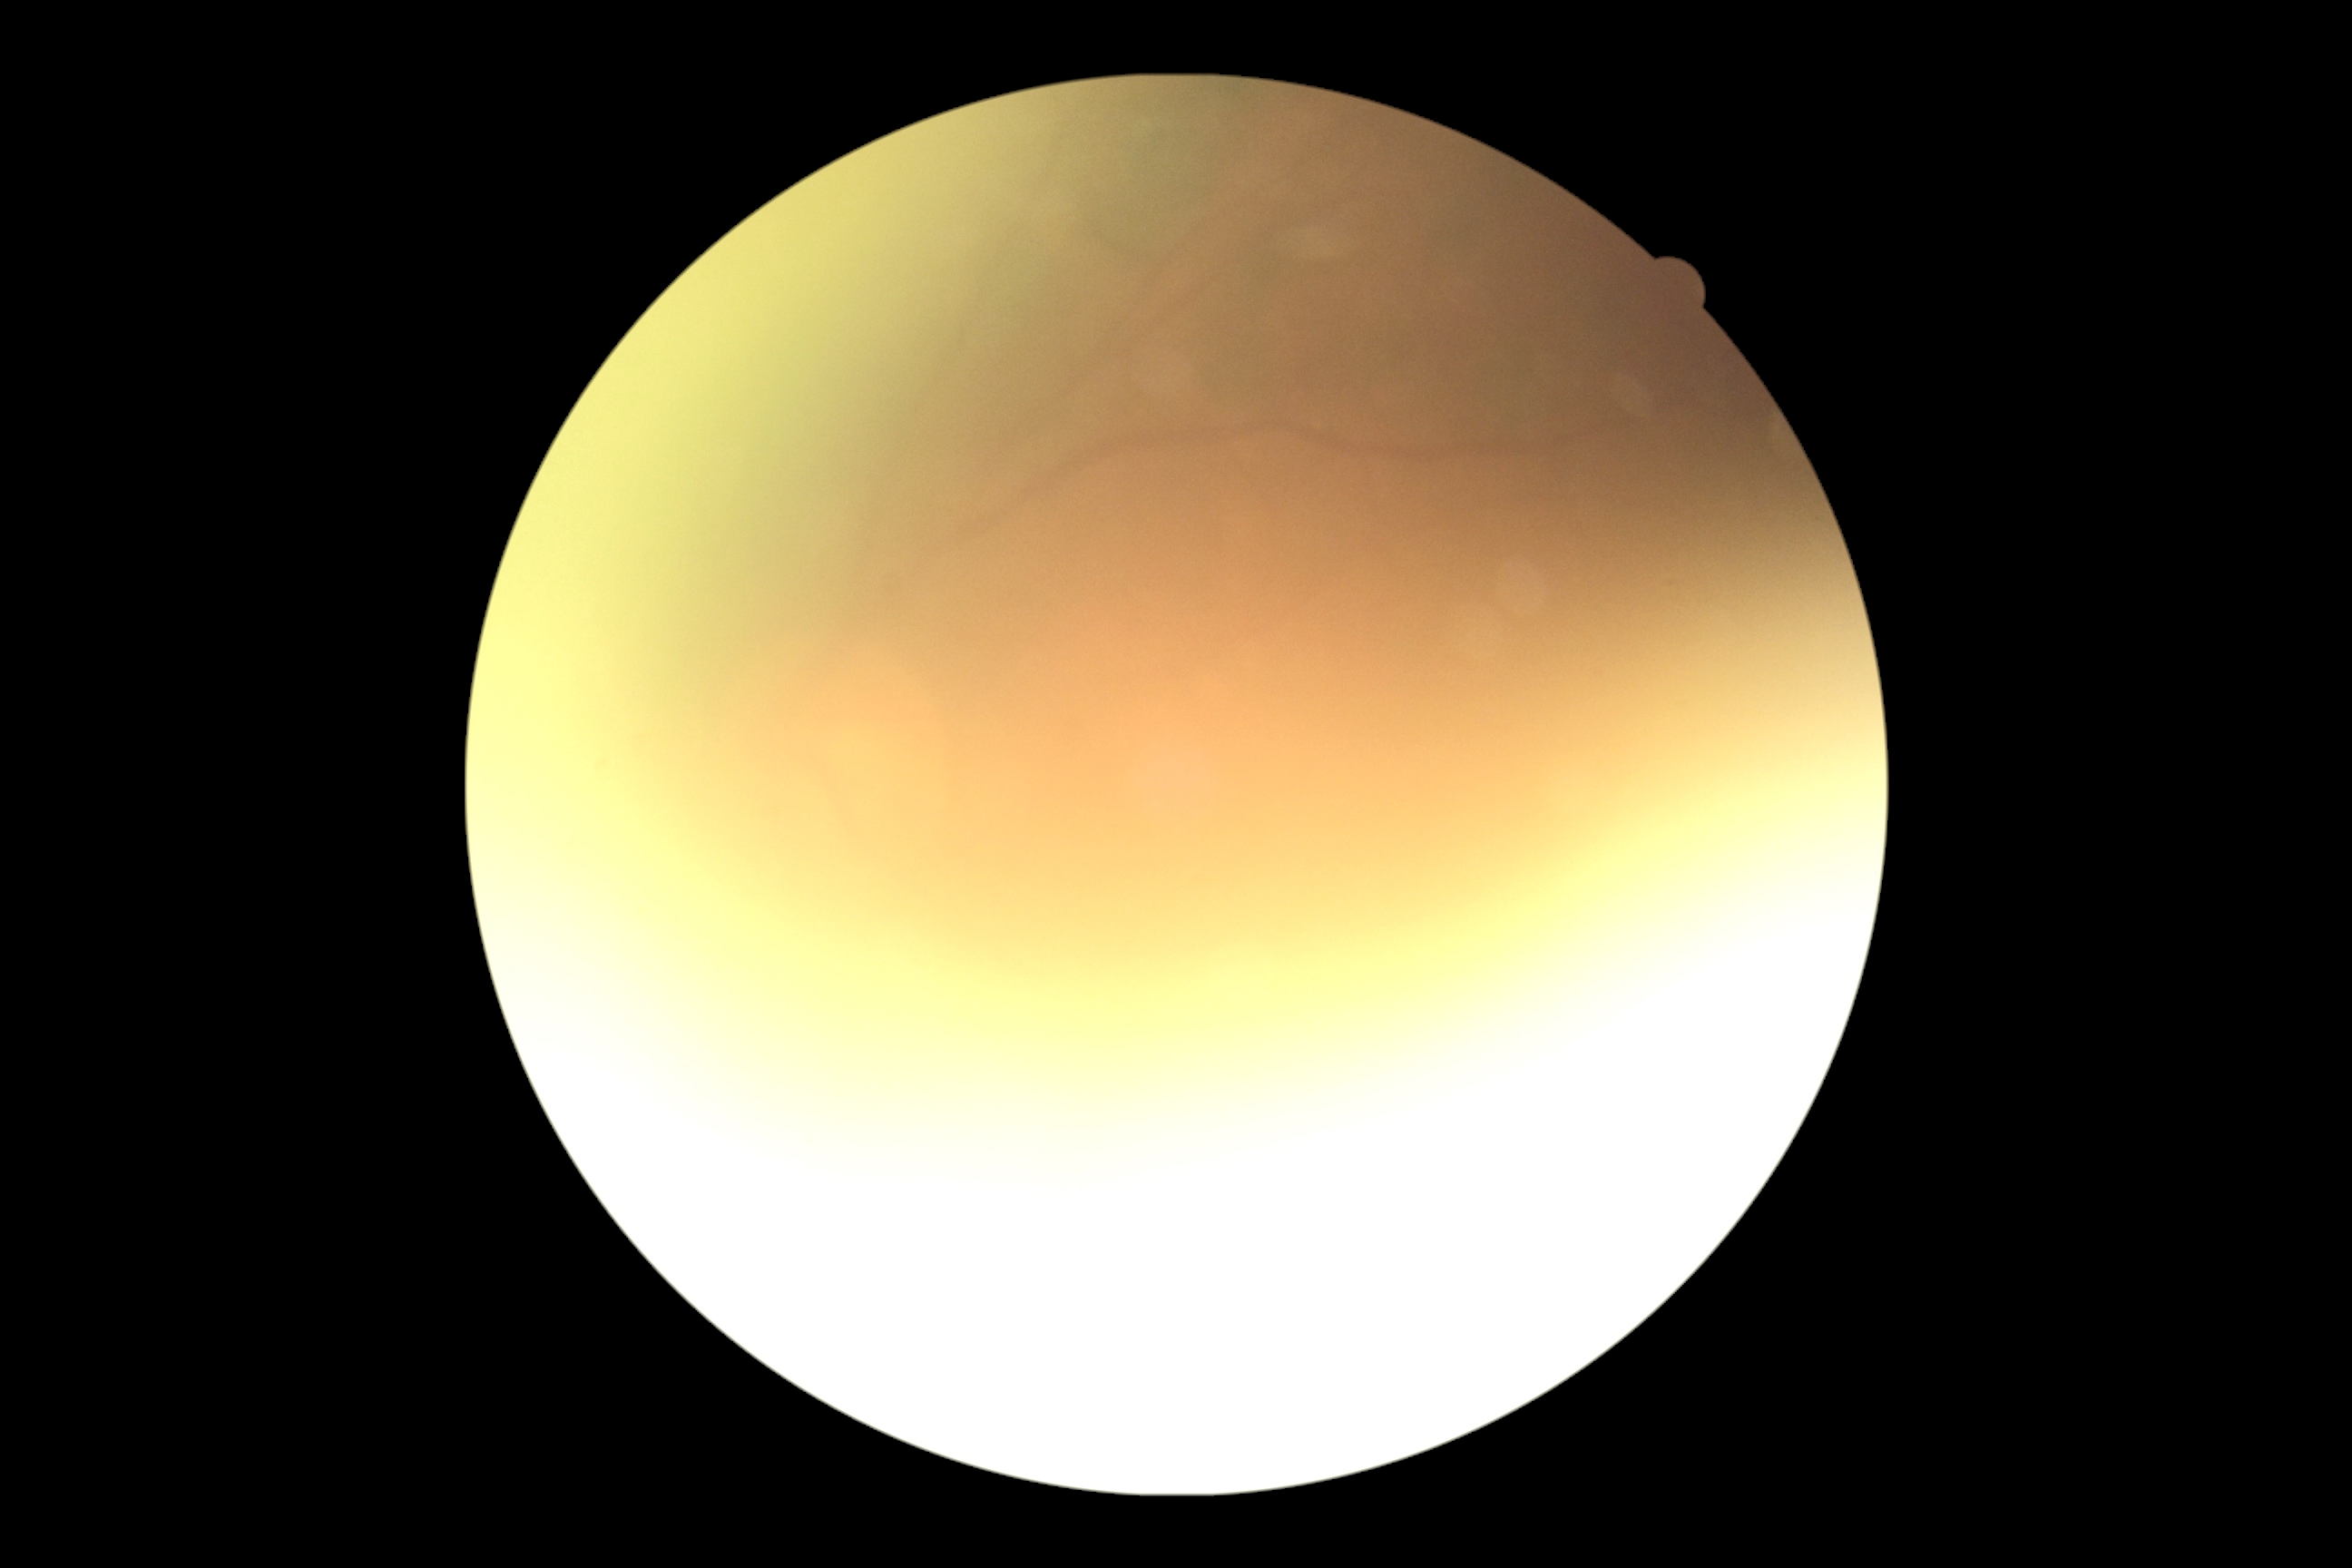 image quality: insufficient for DR assessment; DR grade: ungradable due to poor image quality.